1659 by 2212 pixels, retinal fundus photograph — 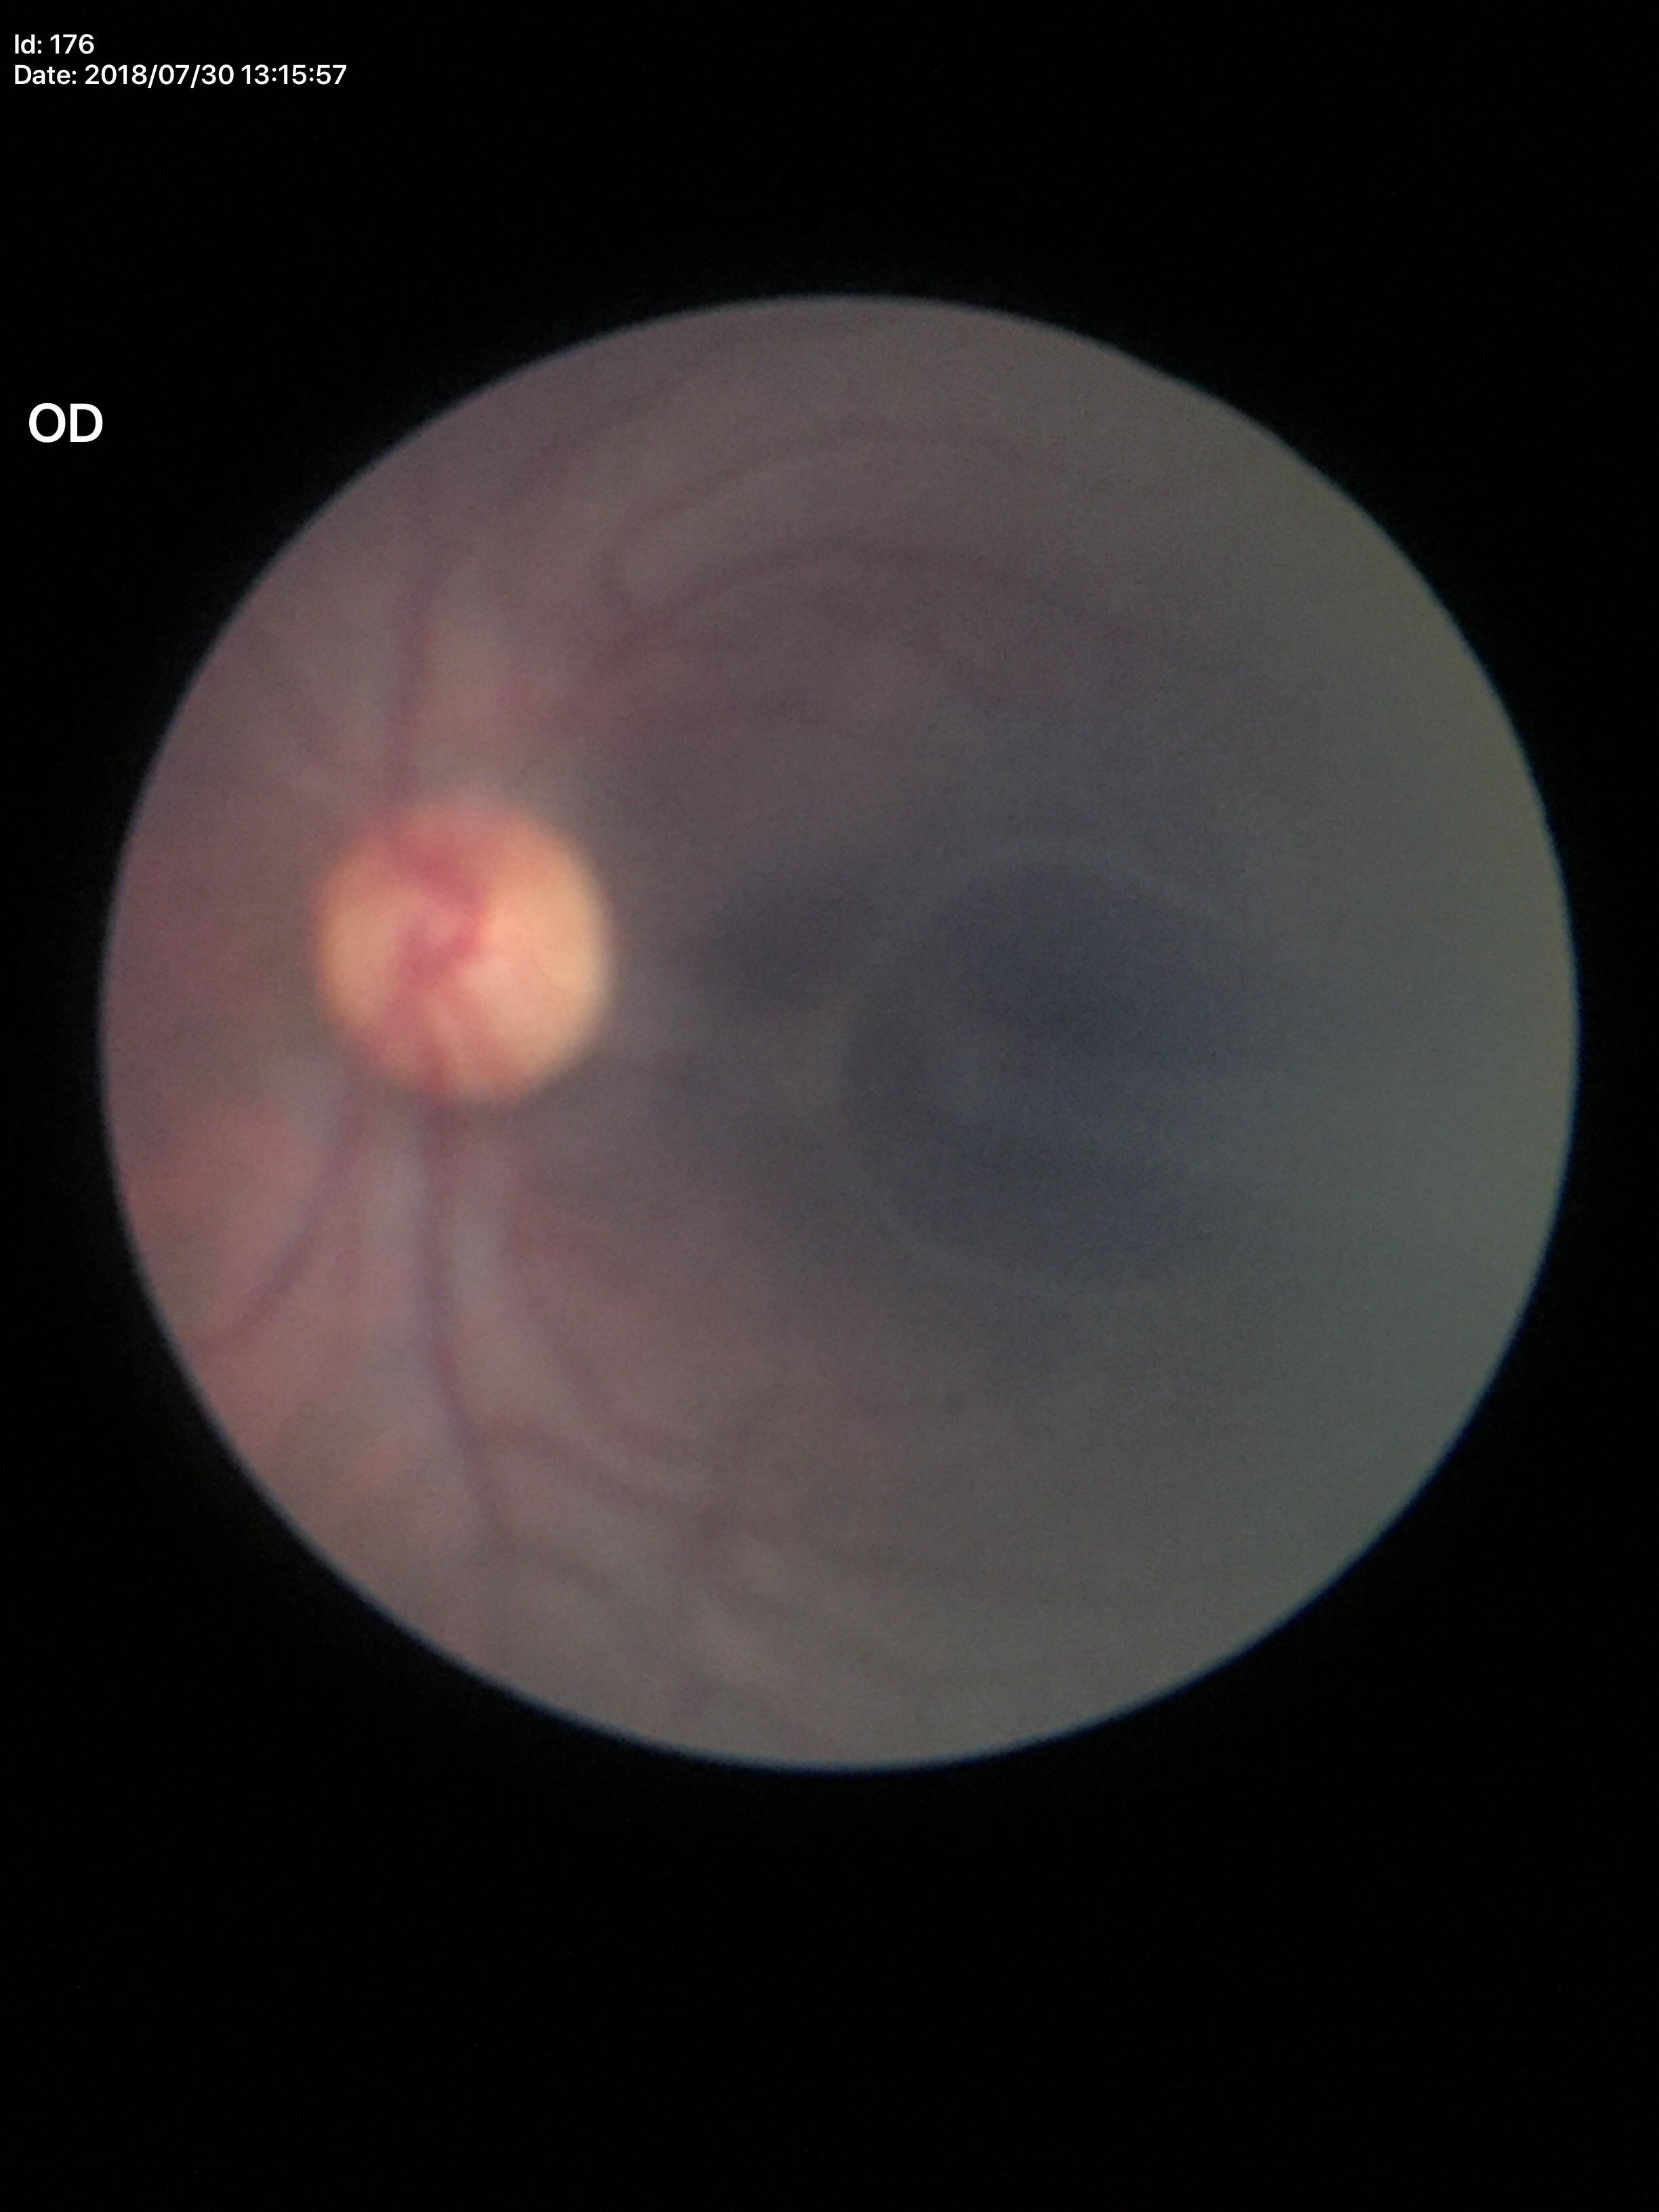 Annotations:
– vertical CDR (VCDR) · 0.46
– Glaucoma assessment · not suspect (5/5 ophthalmologists in agreement)
– horizontal cup-to-disc ratio (HCDR) · 0.48